Wide-field contact fundus photograph of an infant; 1240 by 1240 pixels.
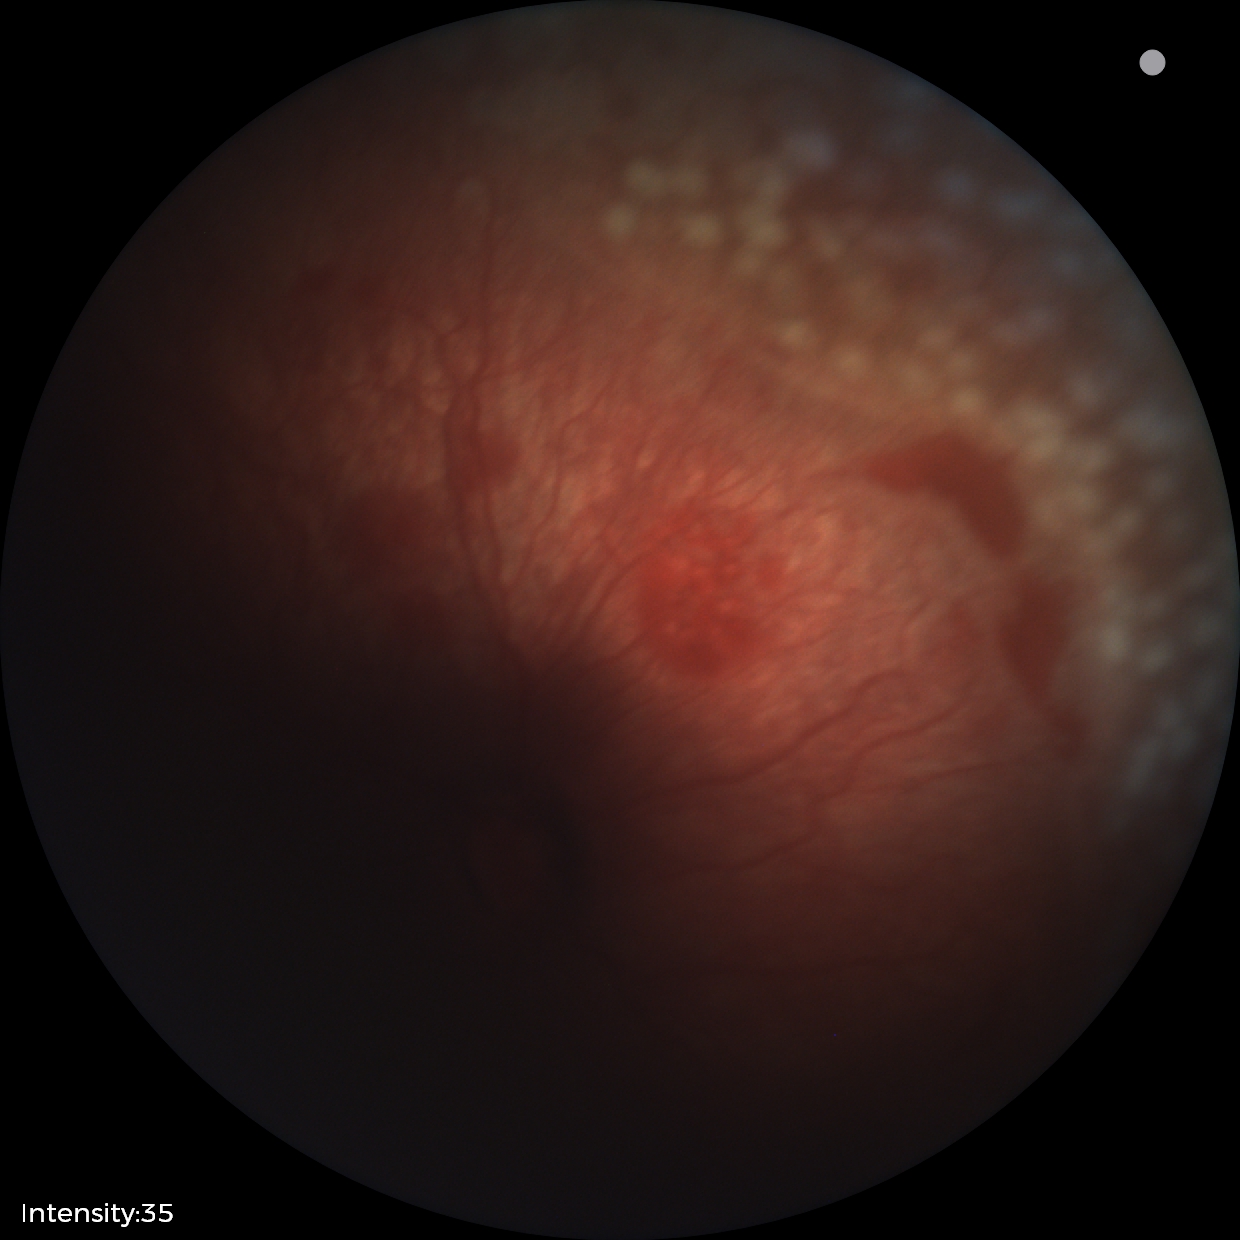
With plus disease. Series diagnosed as retinopathy of prematurity stage 2.